FOV: 50 degrees.
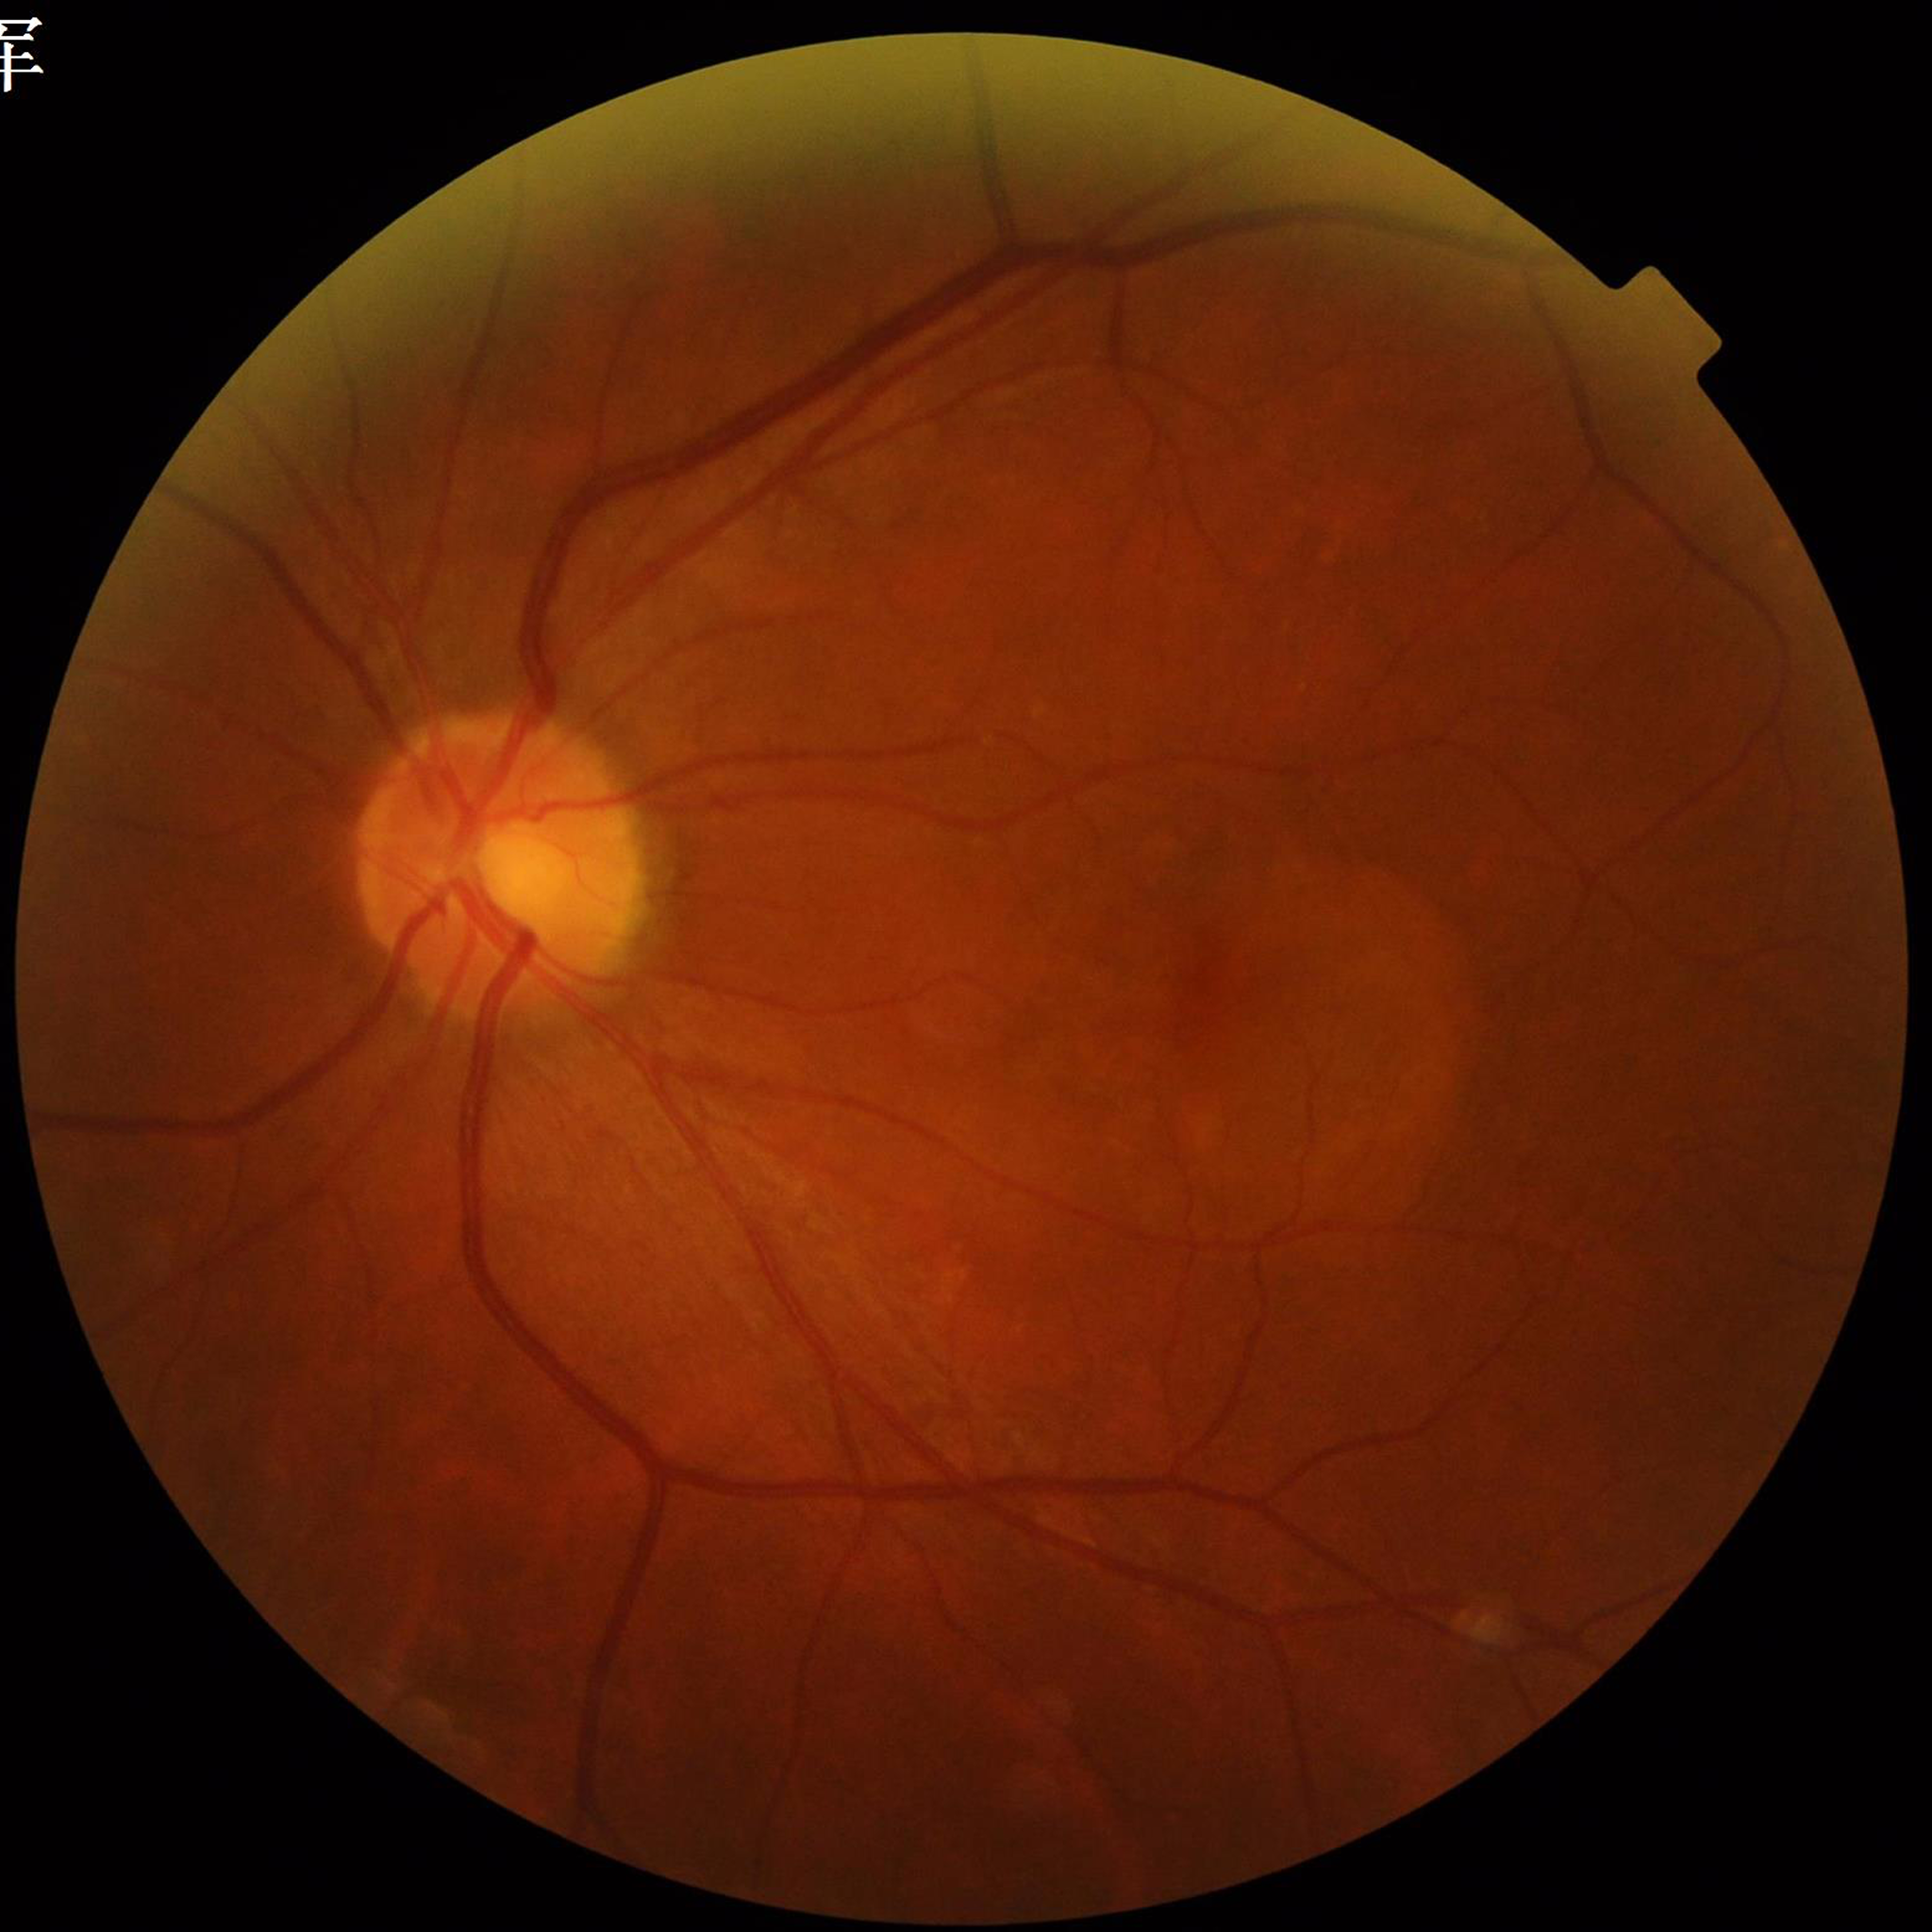
image_quality: adequate
diagnosis: age-related macular degeneration (AMD)